CFP. 45-degree field of view
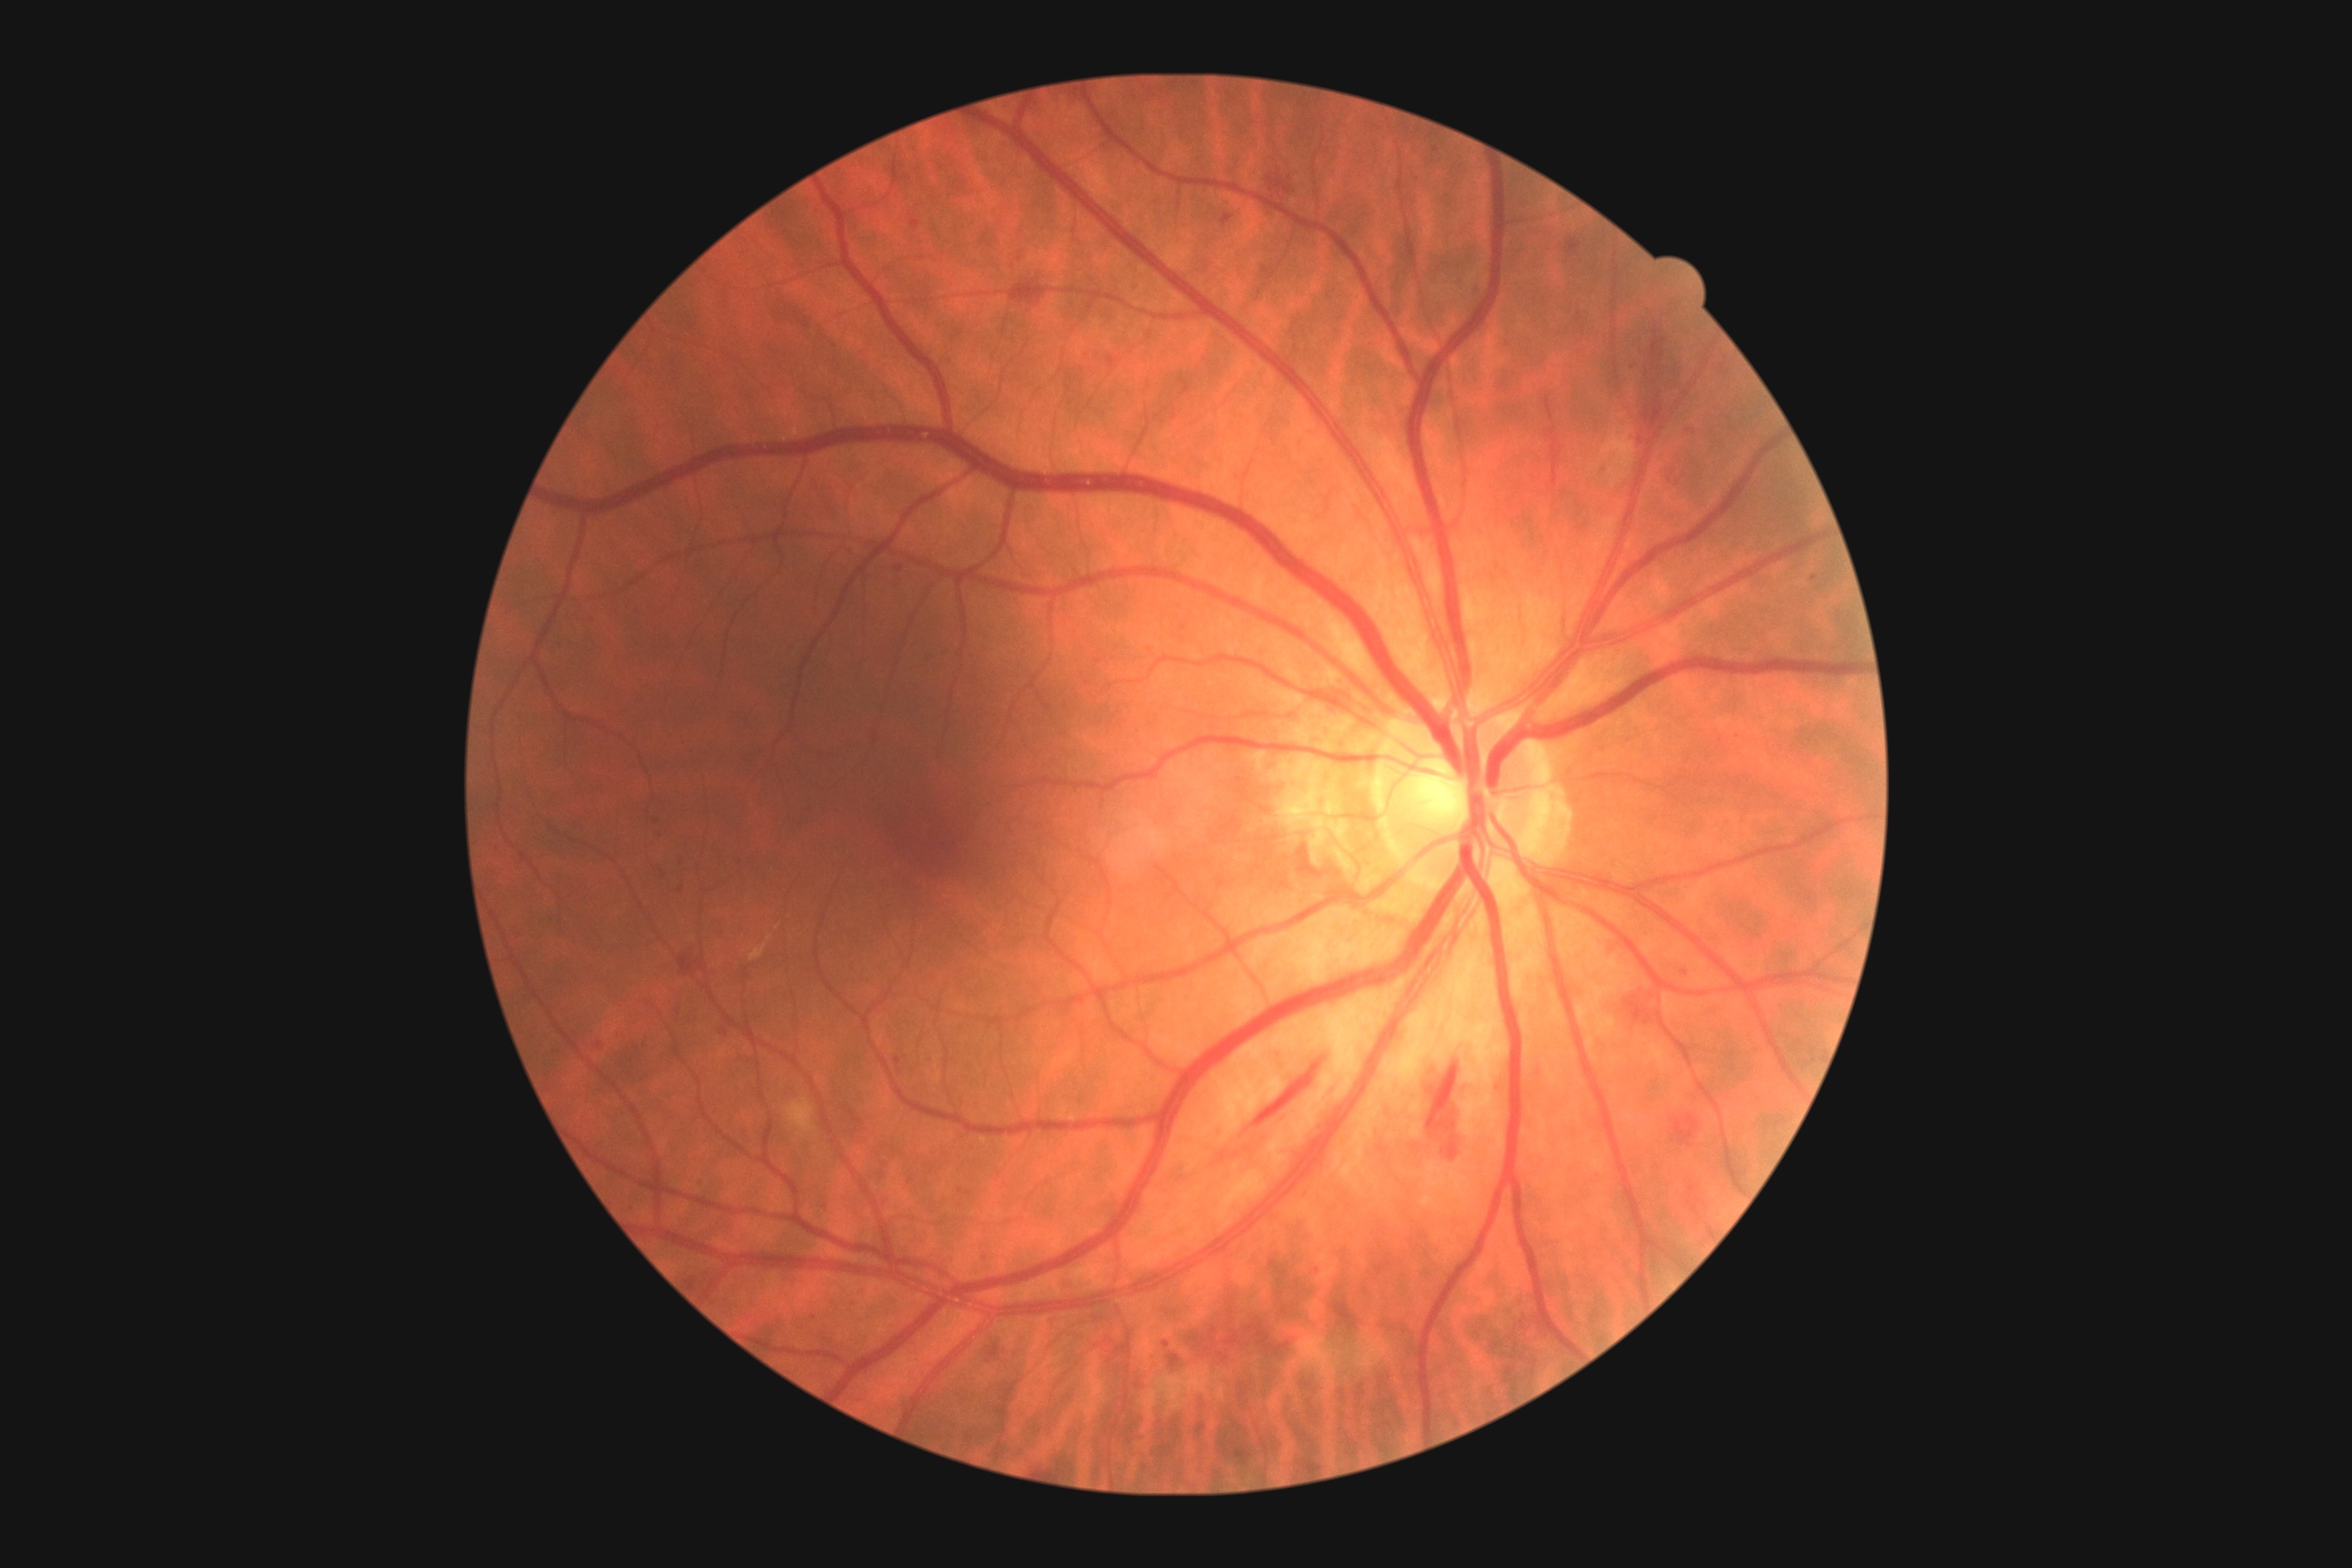 Annotations:
• retinopathy — 2